Modified Davis classification.
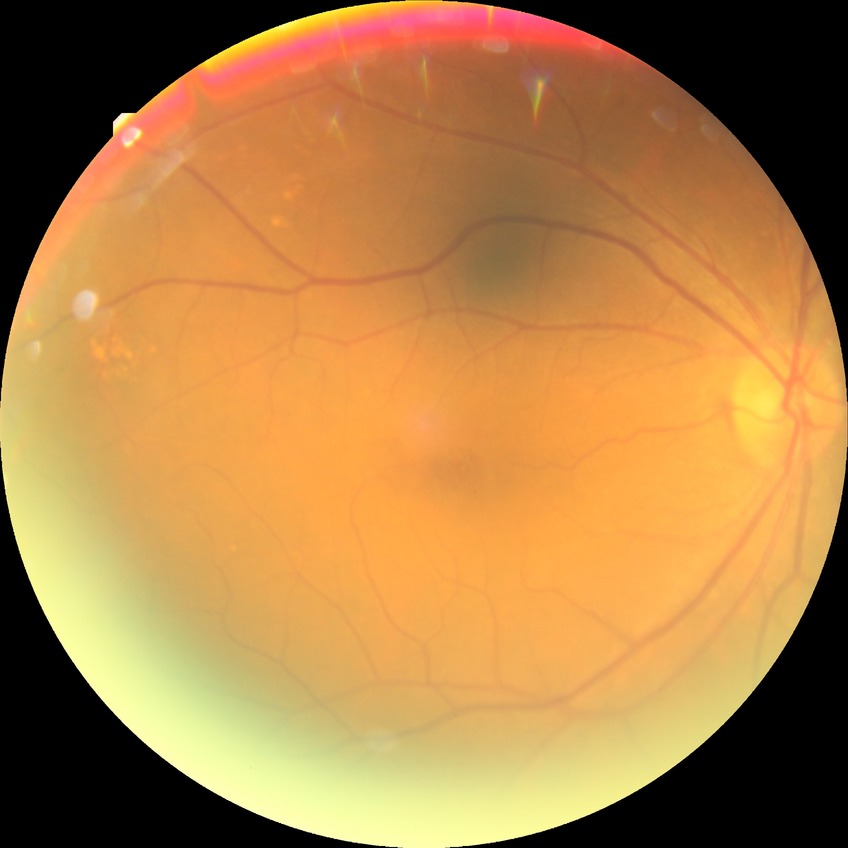
Modified Davis classification is no diabetic retinopathy.